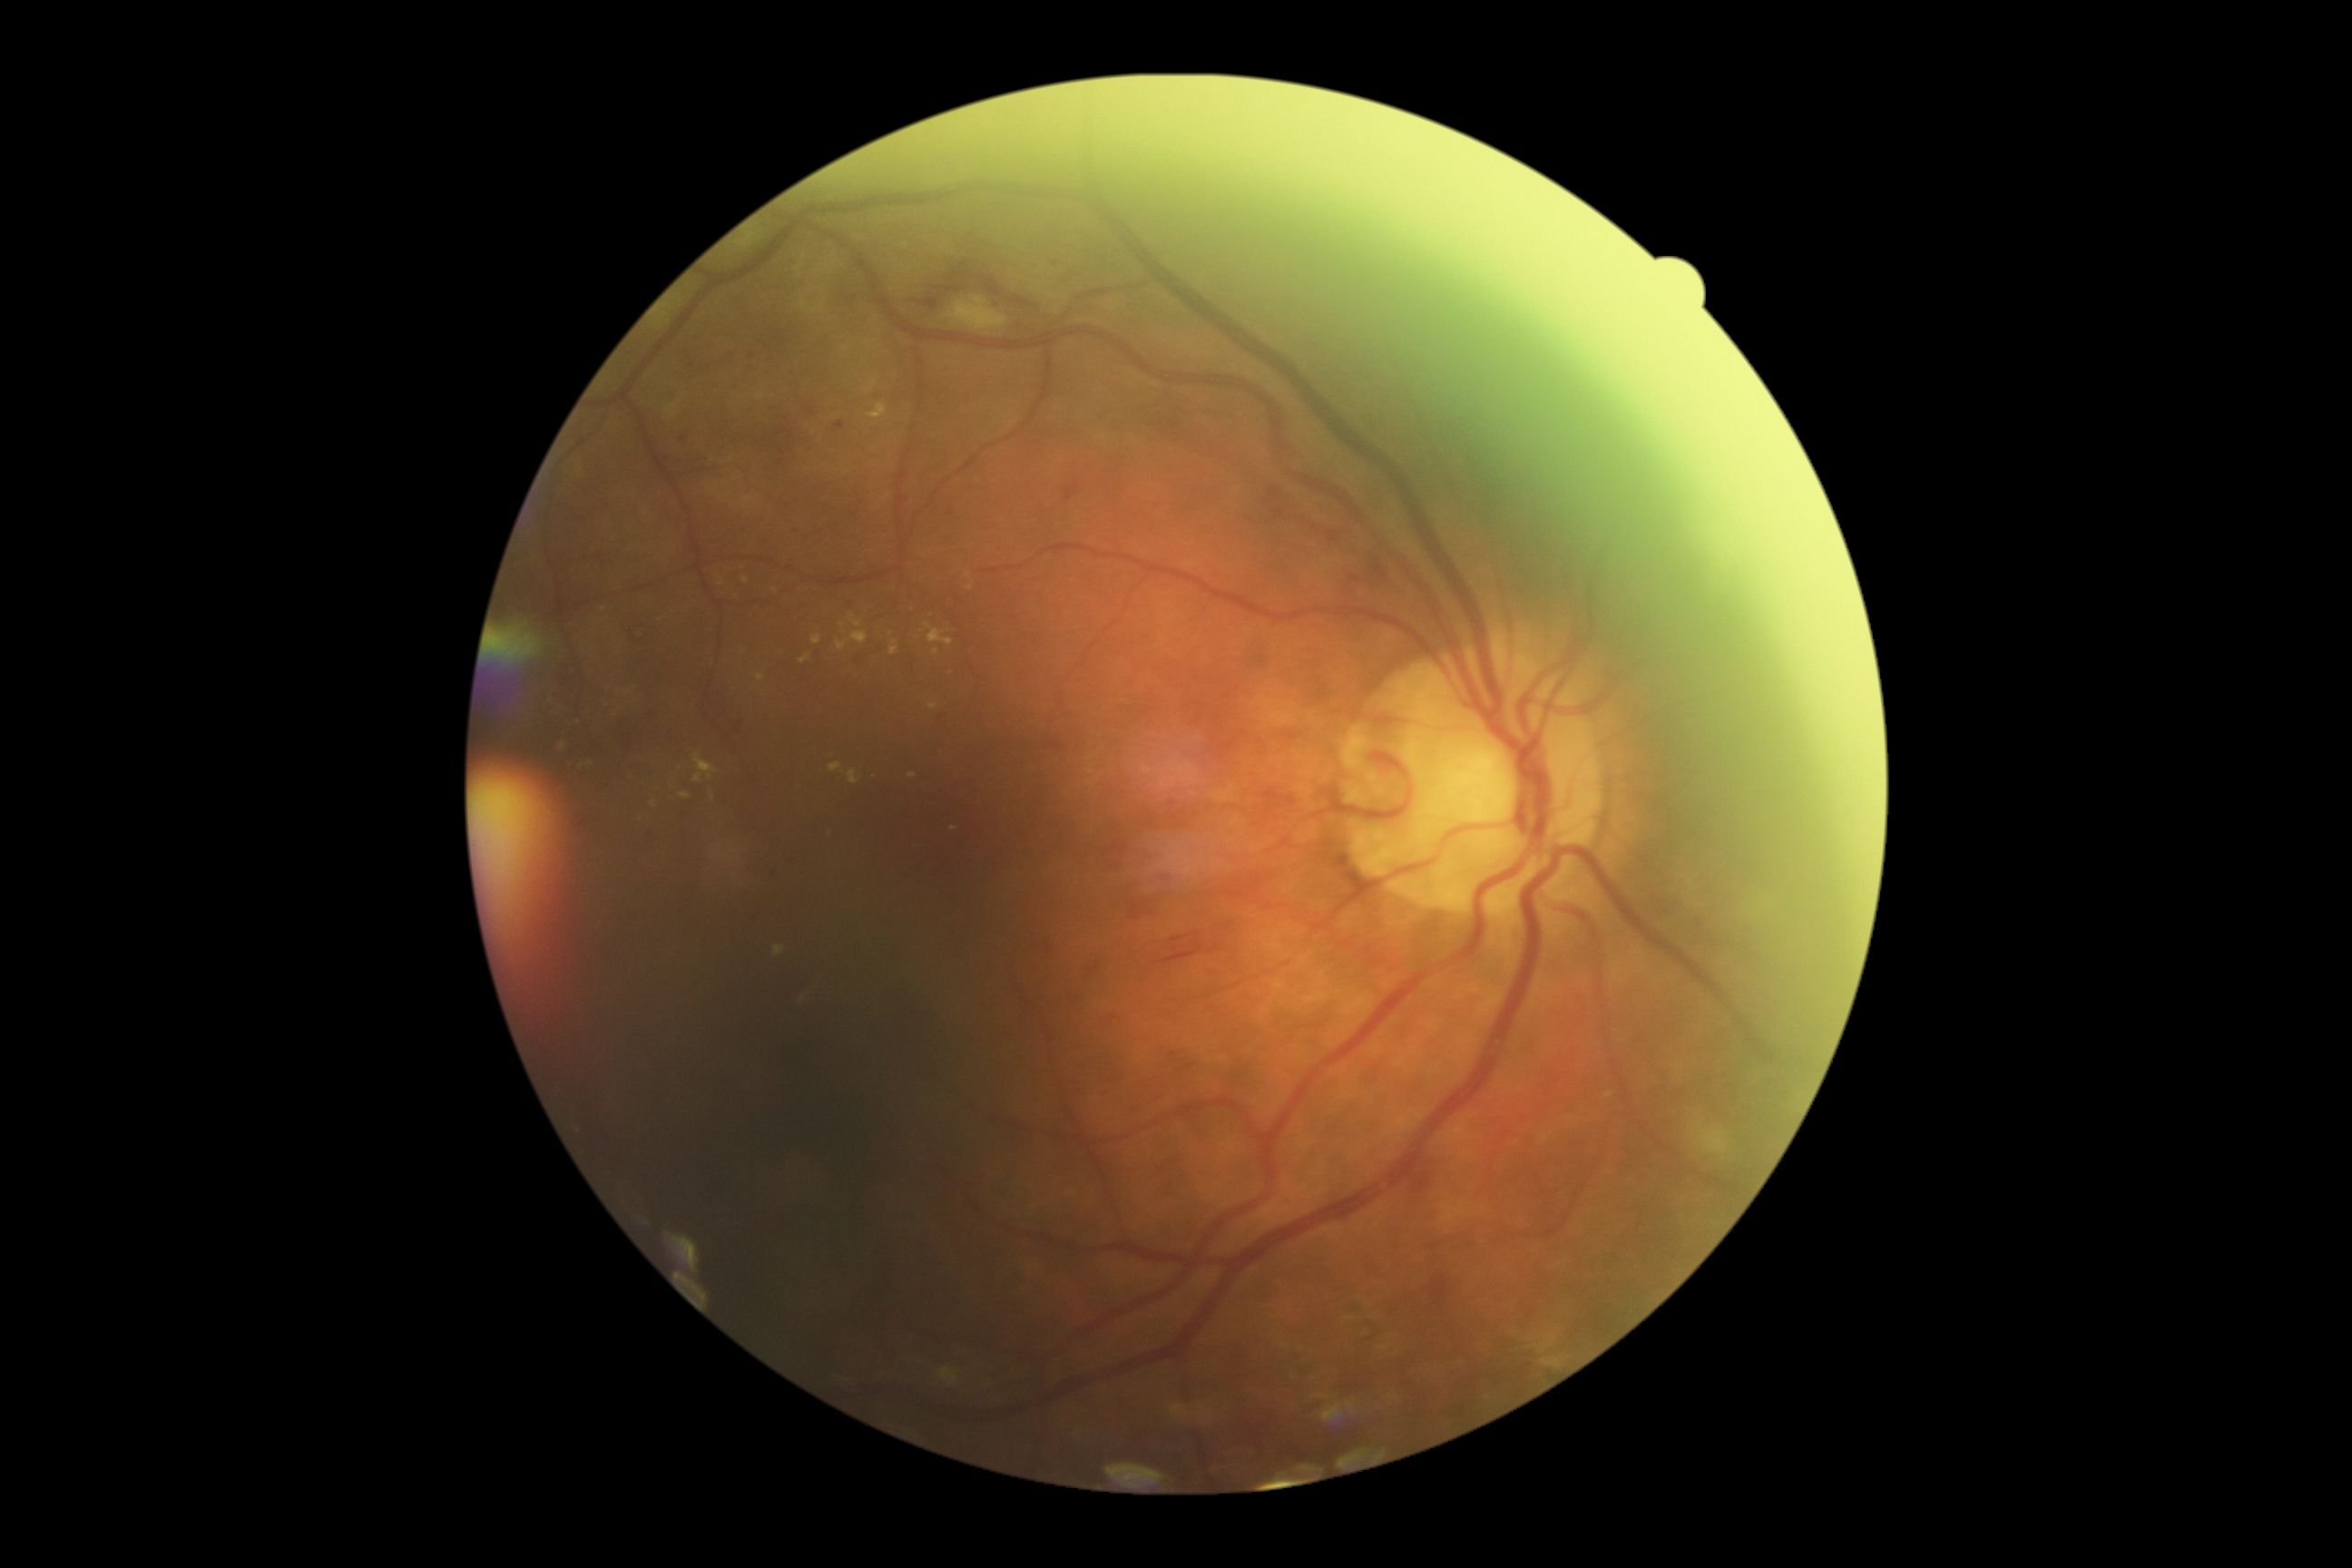
DR stage is moderate non-proliferative diabetic retinopathy (grade 2). Disease class: non-proliferative diabetic retinopathy.